1659 by 2212 pixels: 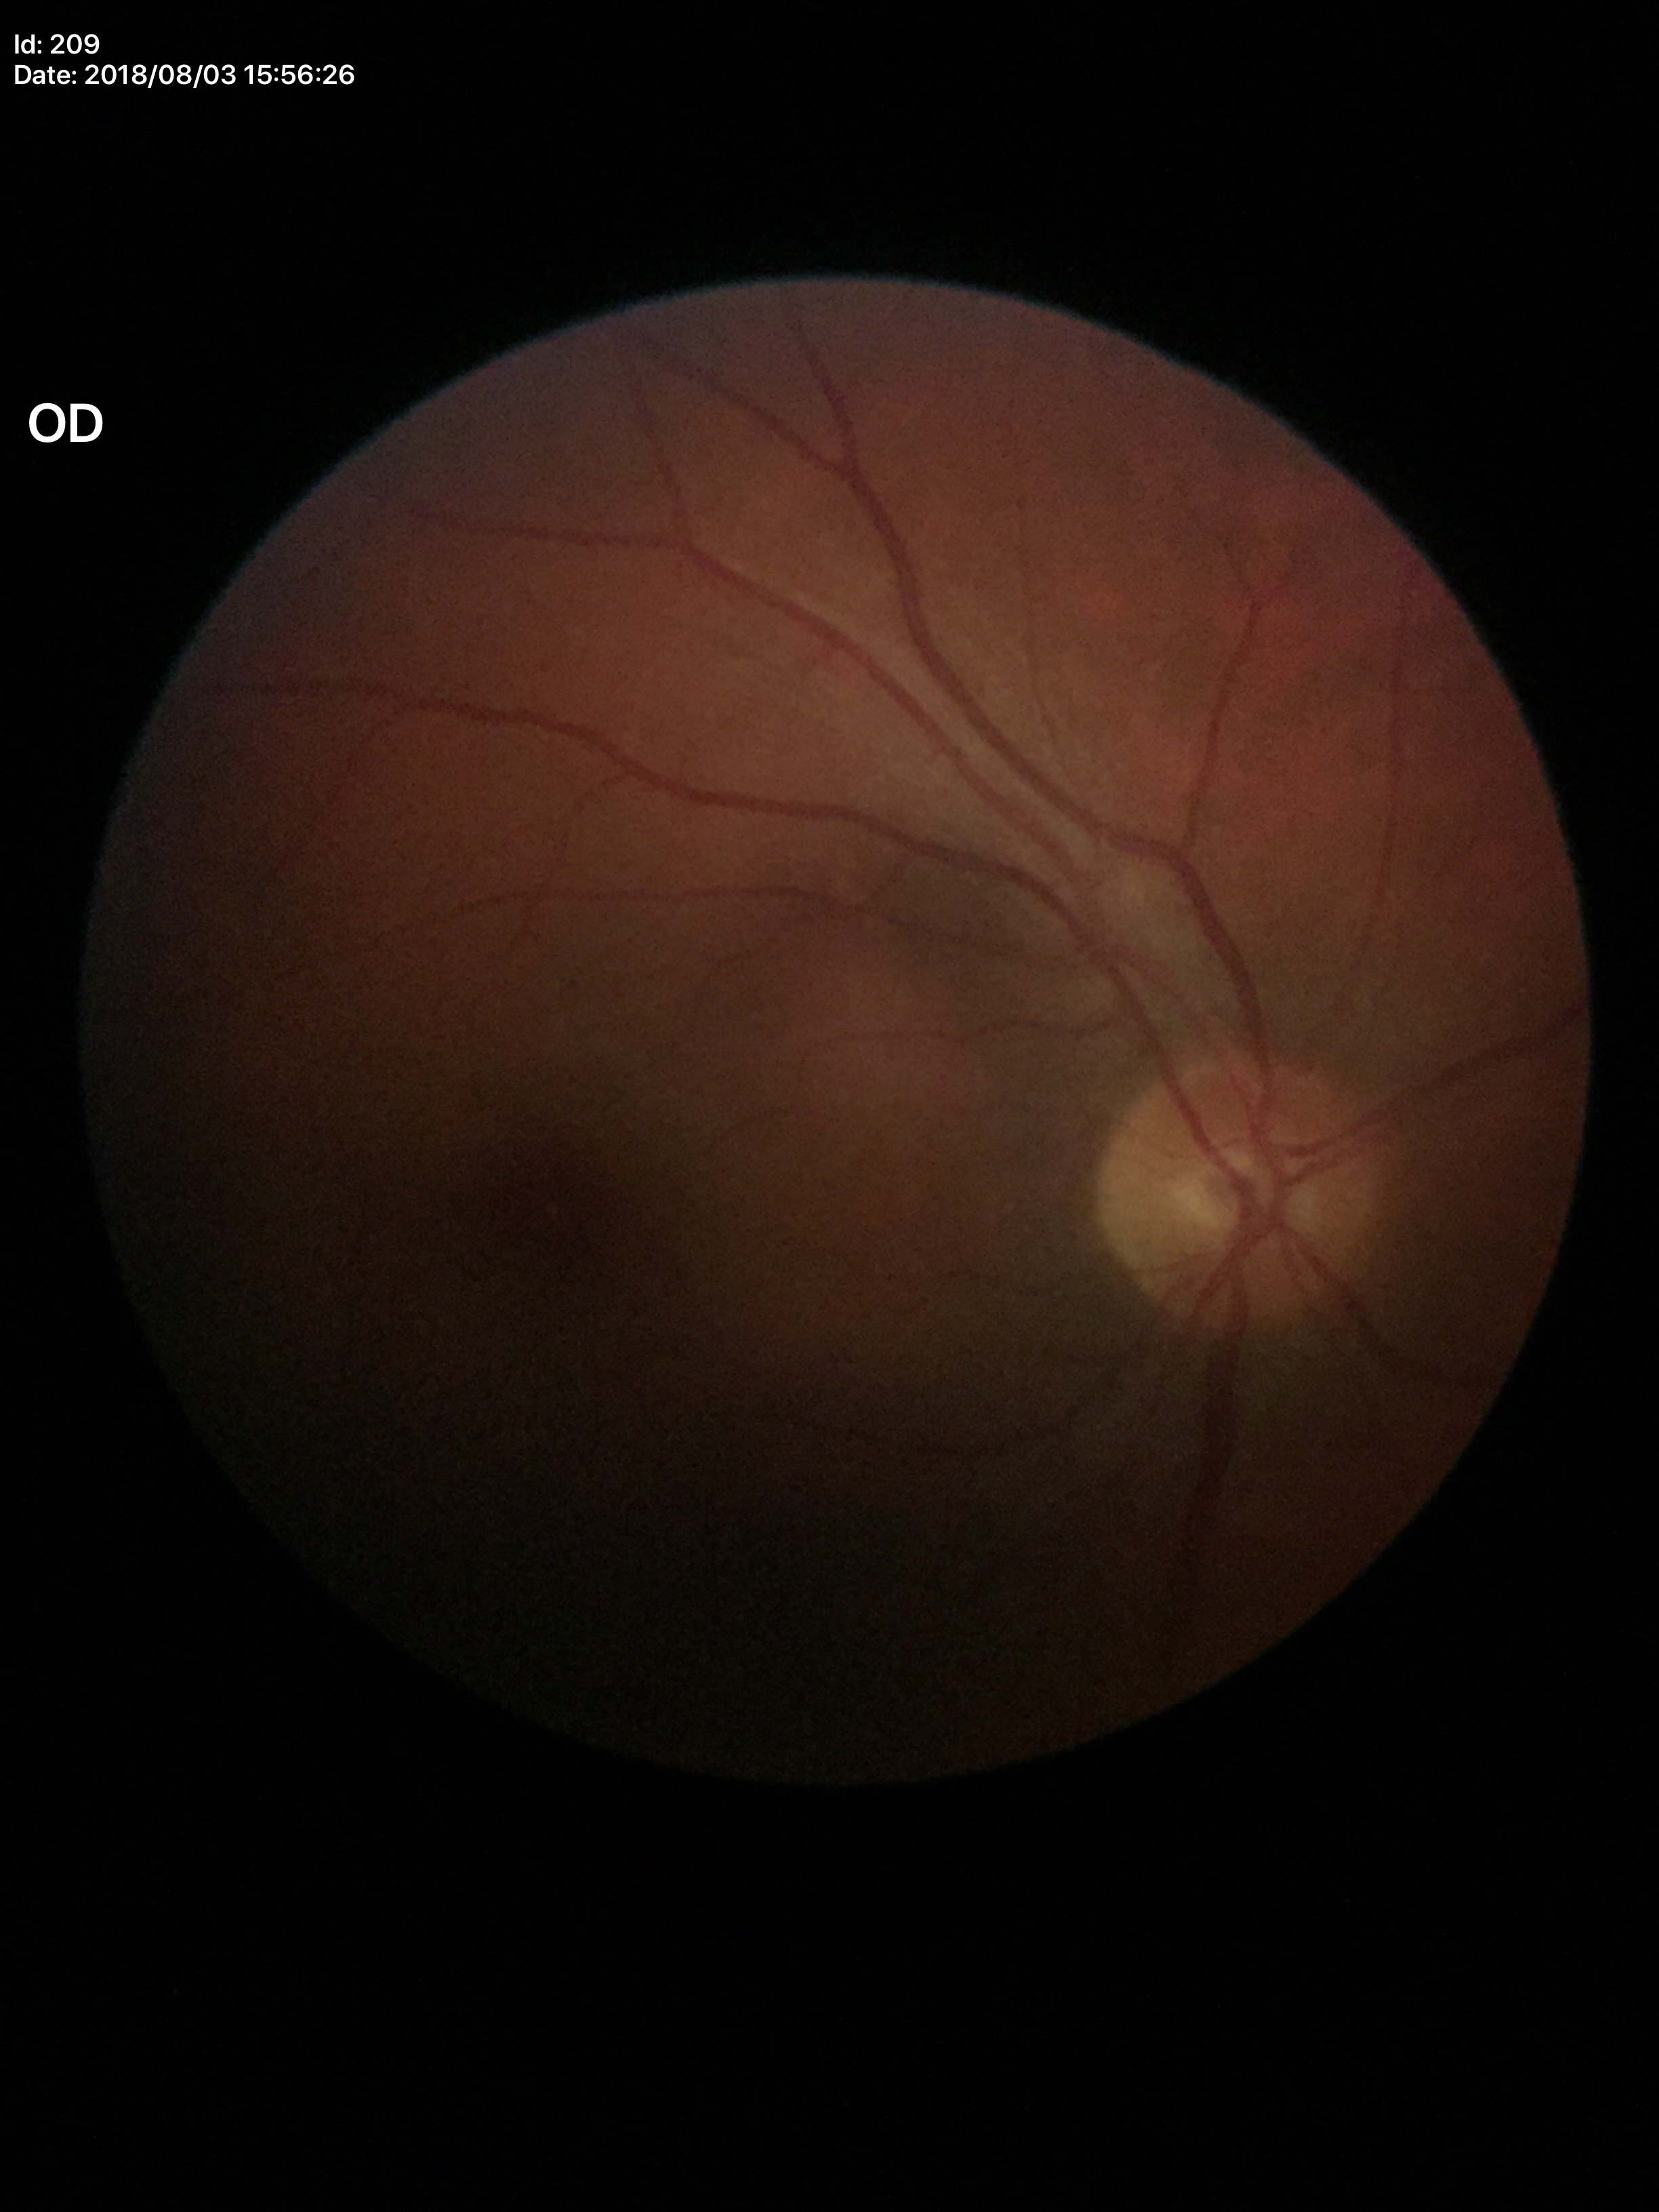

Findings:
* Glaucoma screening: no suspicious findings (5/5 ophthalmologists in agreement)
* vertical CDR (VCDR): 0.47